Nonmydriatic fundus photograph. Color fundus image. Acquired with a NIDEK AFC-230. 848 by 848 pixels.
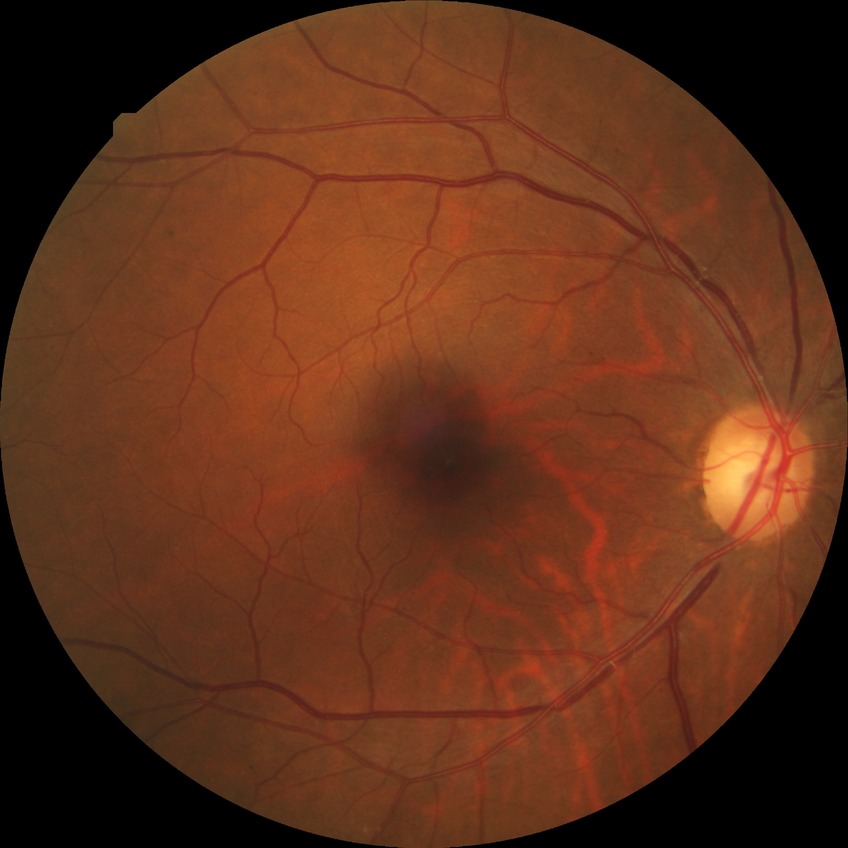

DR class=non-proliferative diabetic retinopathy, diabetic retinopathy (DR)=simple diabetic retinopathy (SDR).